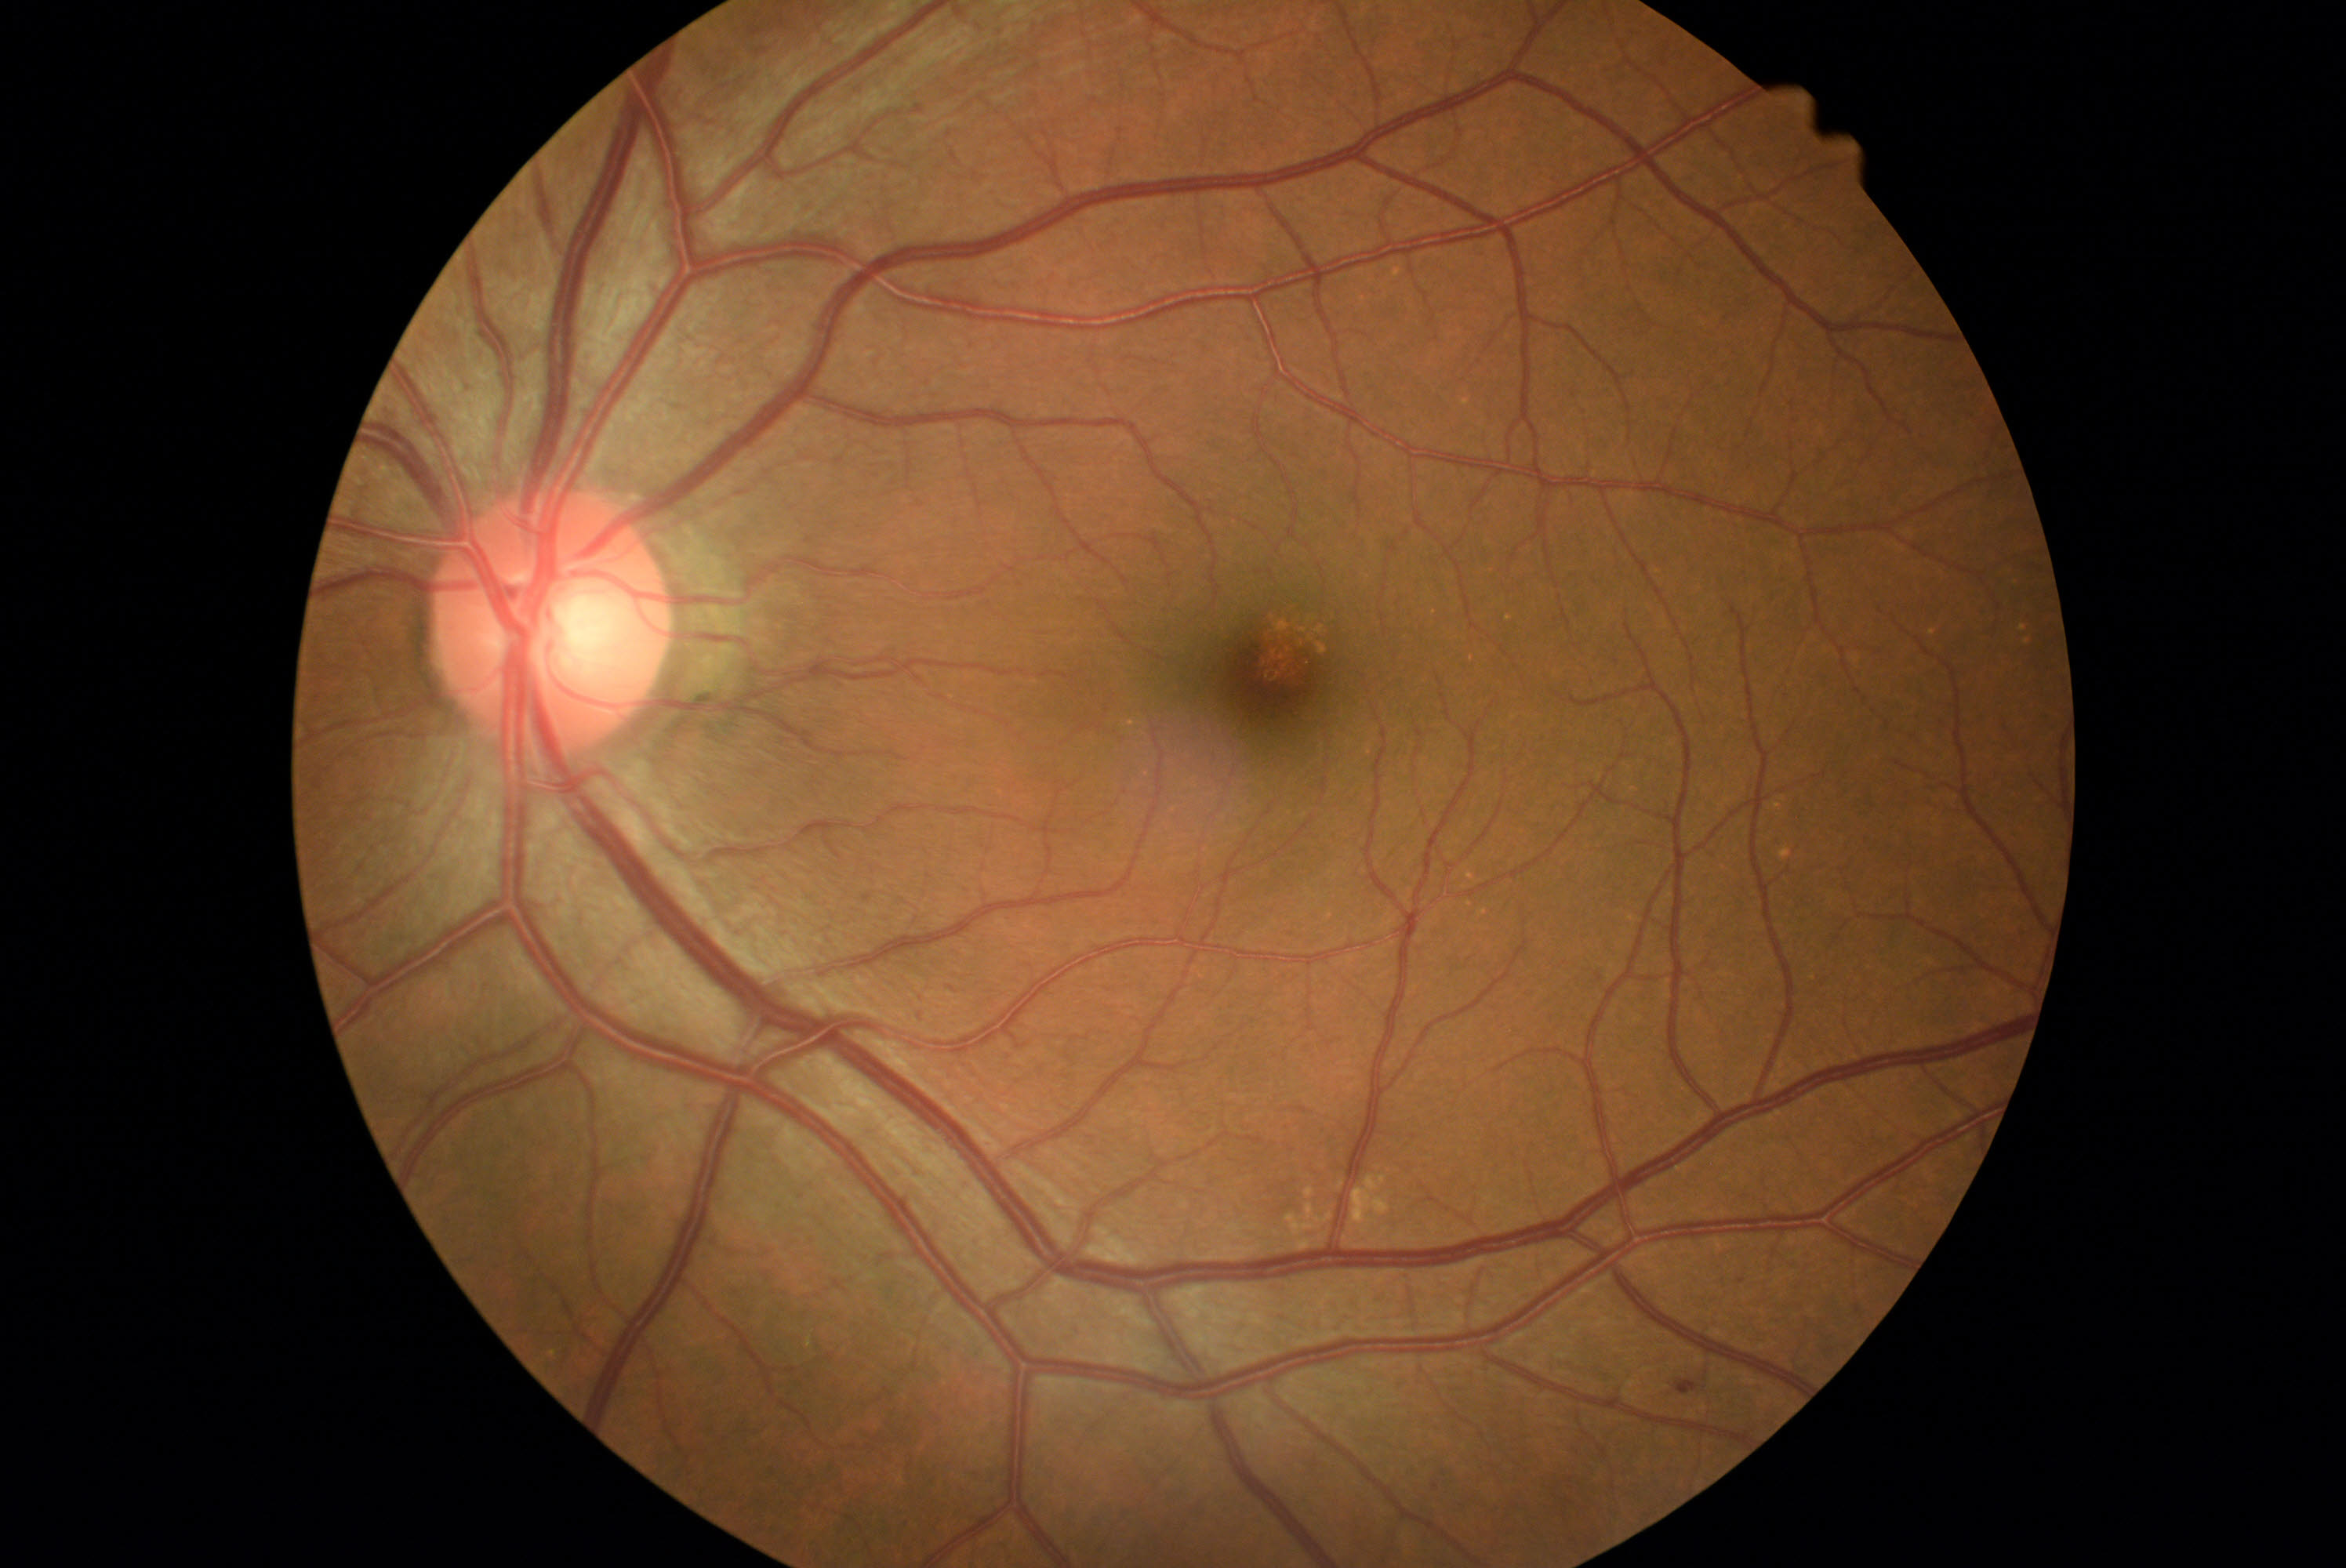
DR severity is mild NPDR (grade 1)
SEs = none identified
MAs = {"left": 1676, "top": 1381, "right": 1699, "bottom": 1396}; {"left": 1738, "top": 1280, "right": 1746, "bottom": 1285}
HEs = none identified
EXs = none identified